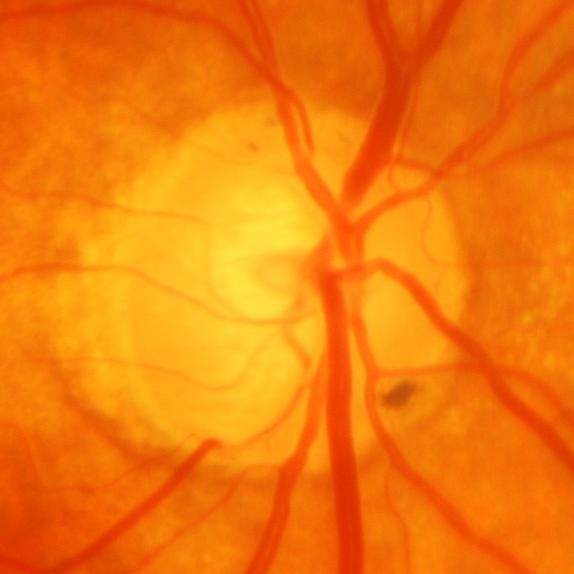
There is evidence of glaucomatous damage to the optic nerve.